45° FOV · 2212x1659px · retinal fundus photograph: 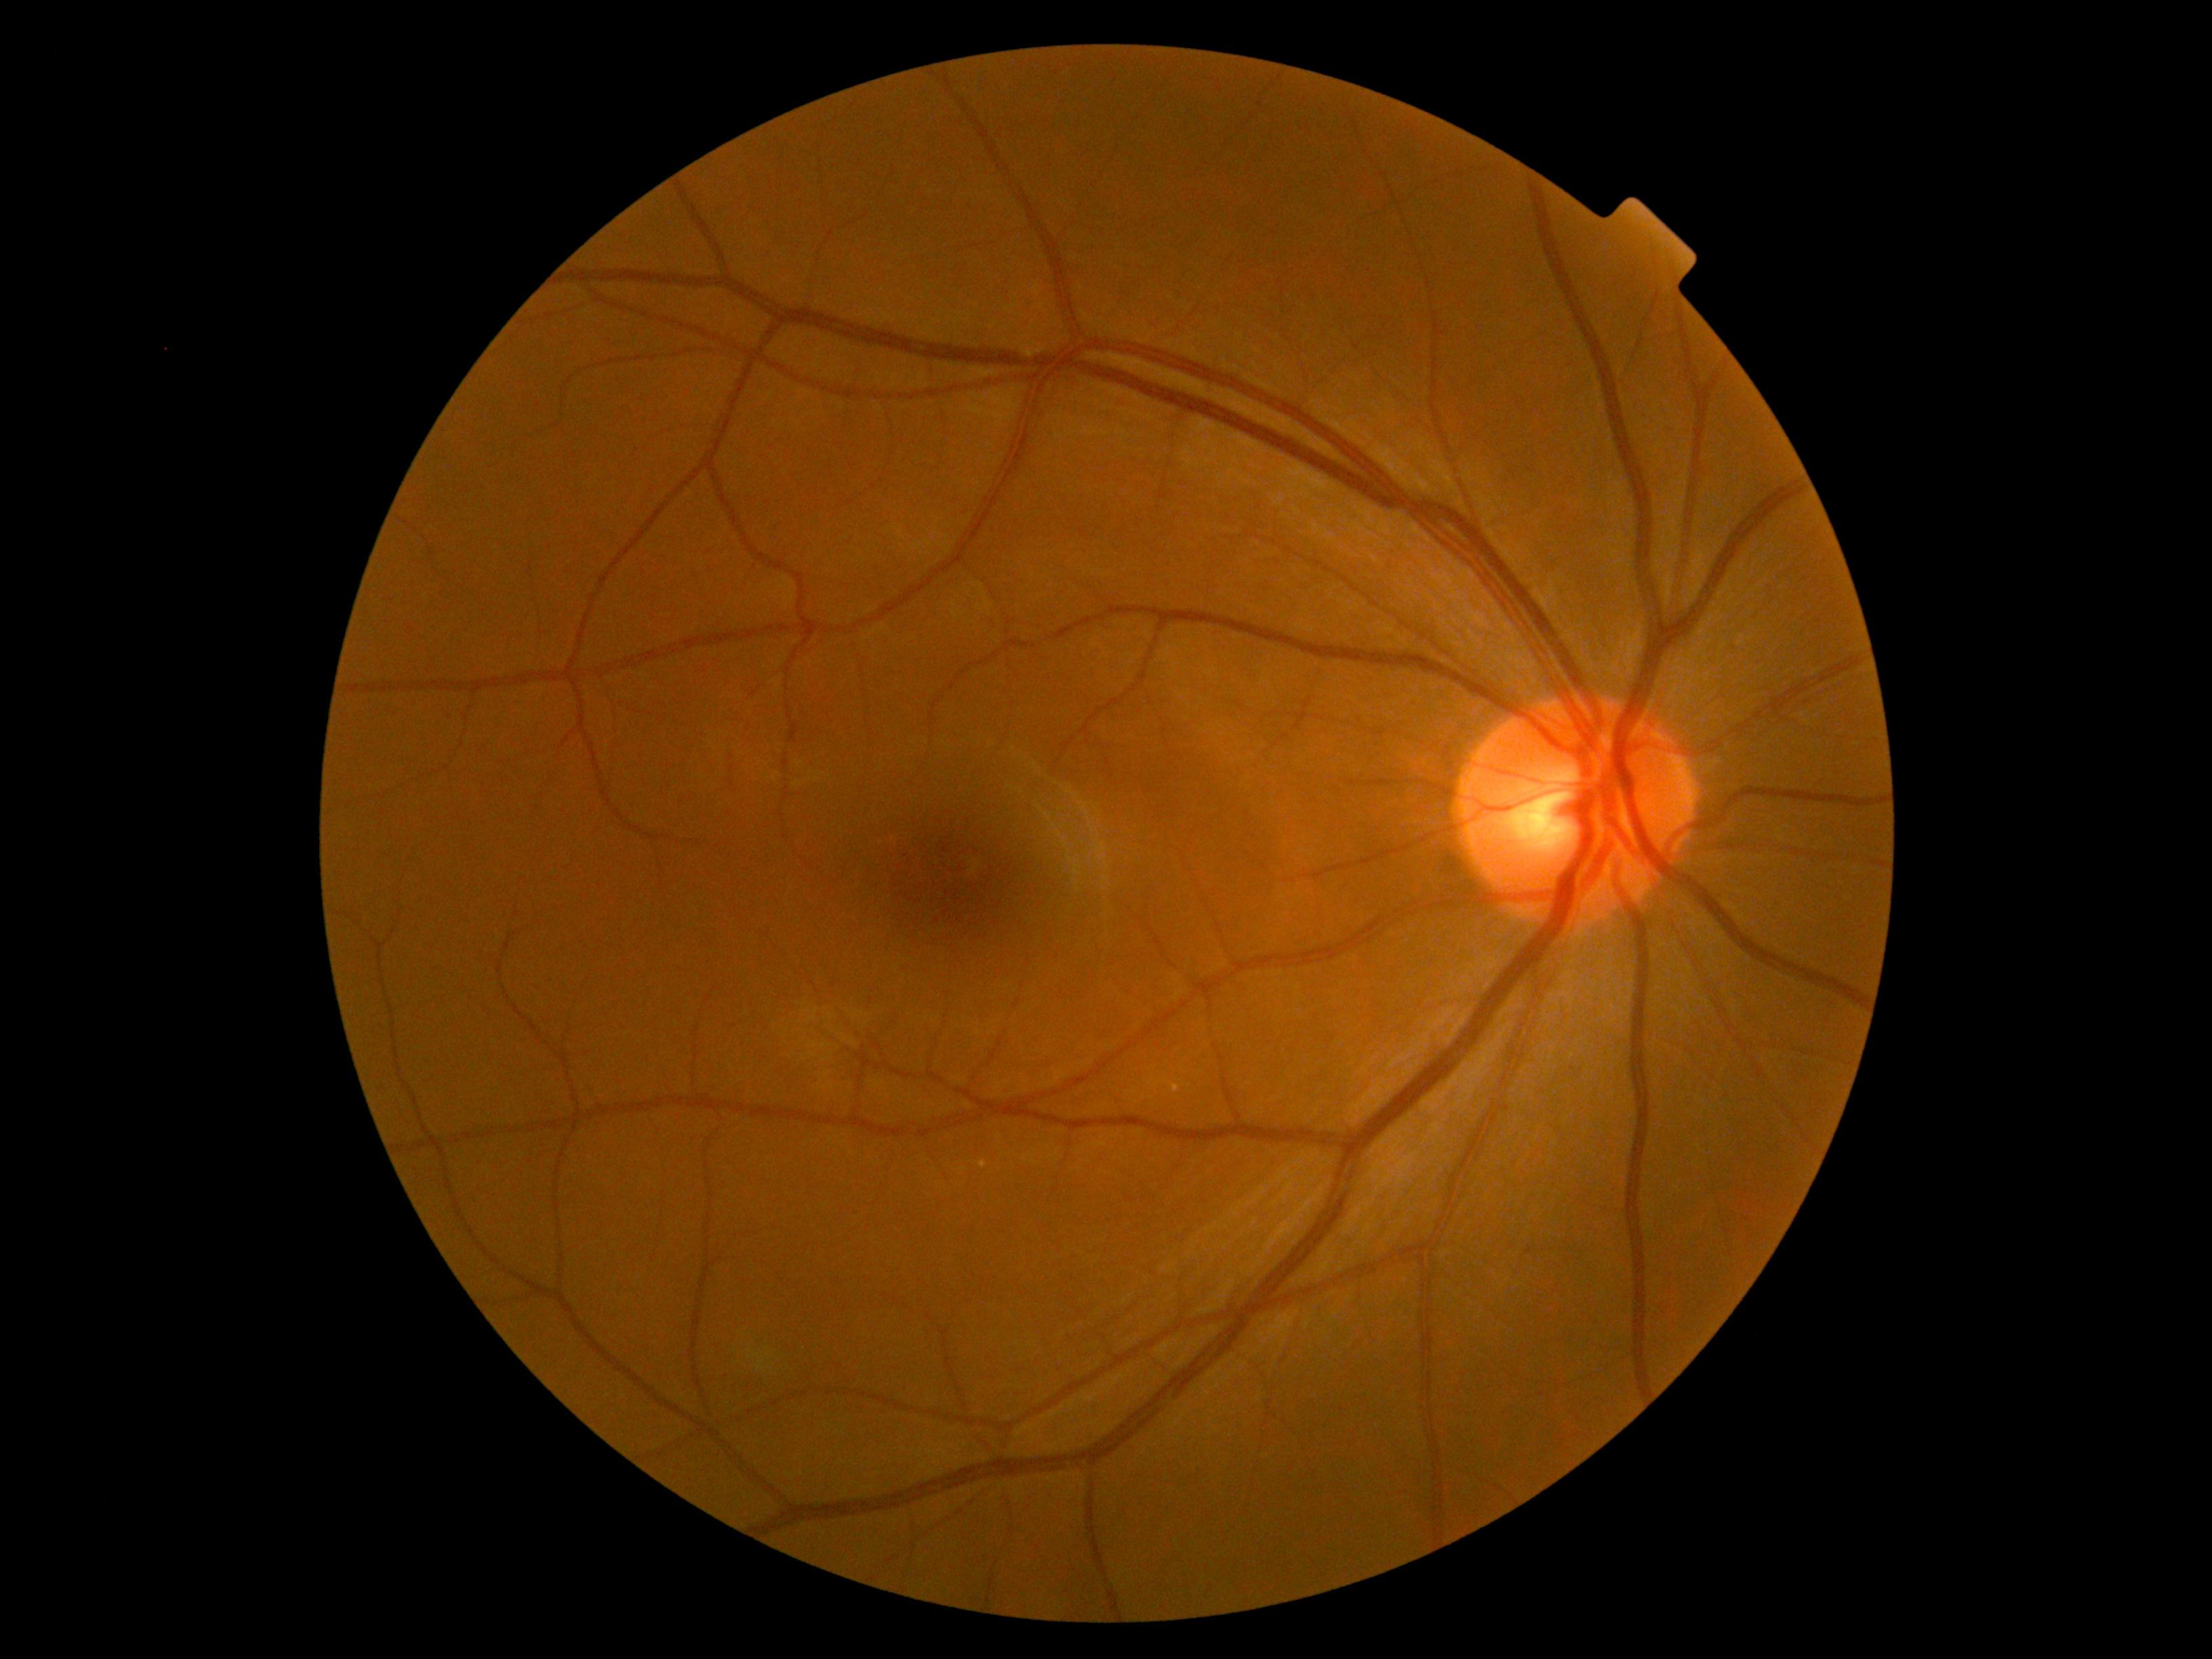 DR: 0 — no visible signs of diabetic retinopathy.